2352 x 1568 pixels · color fundus photograph:
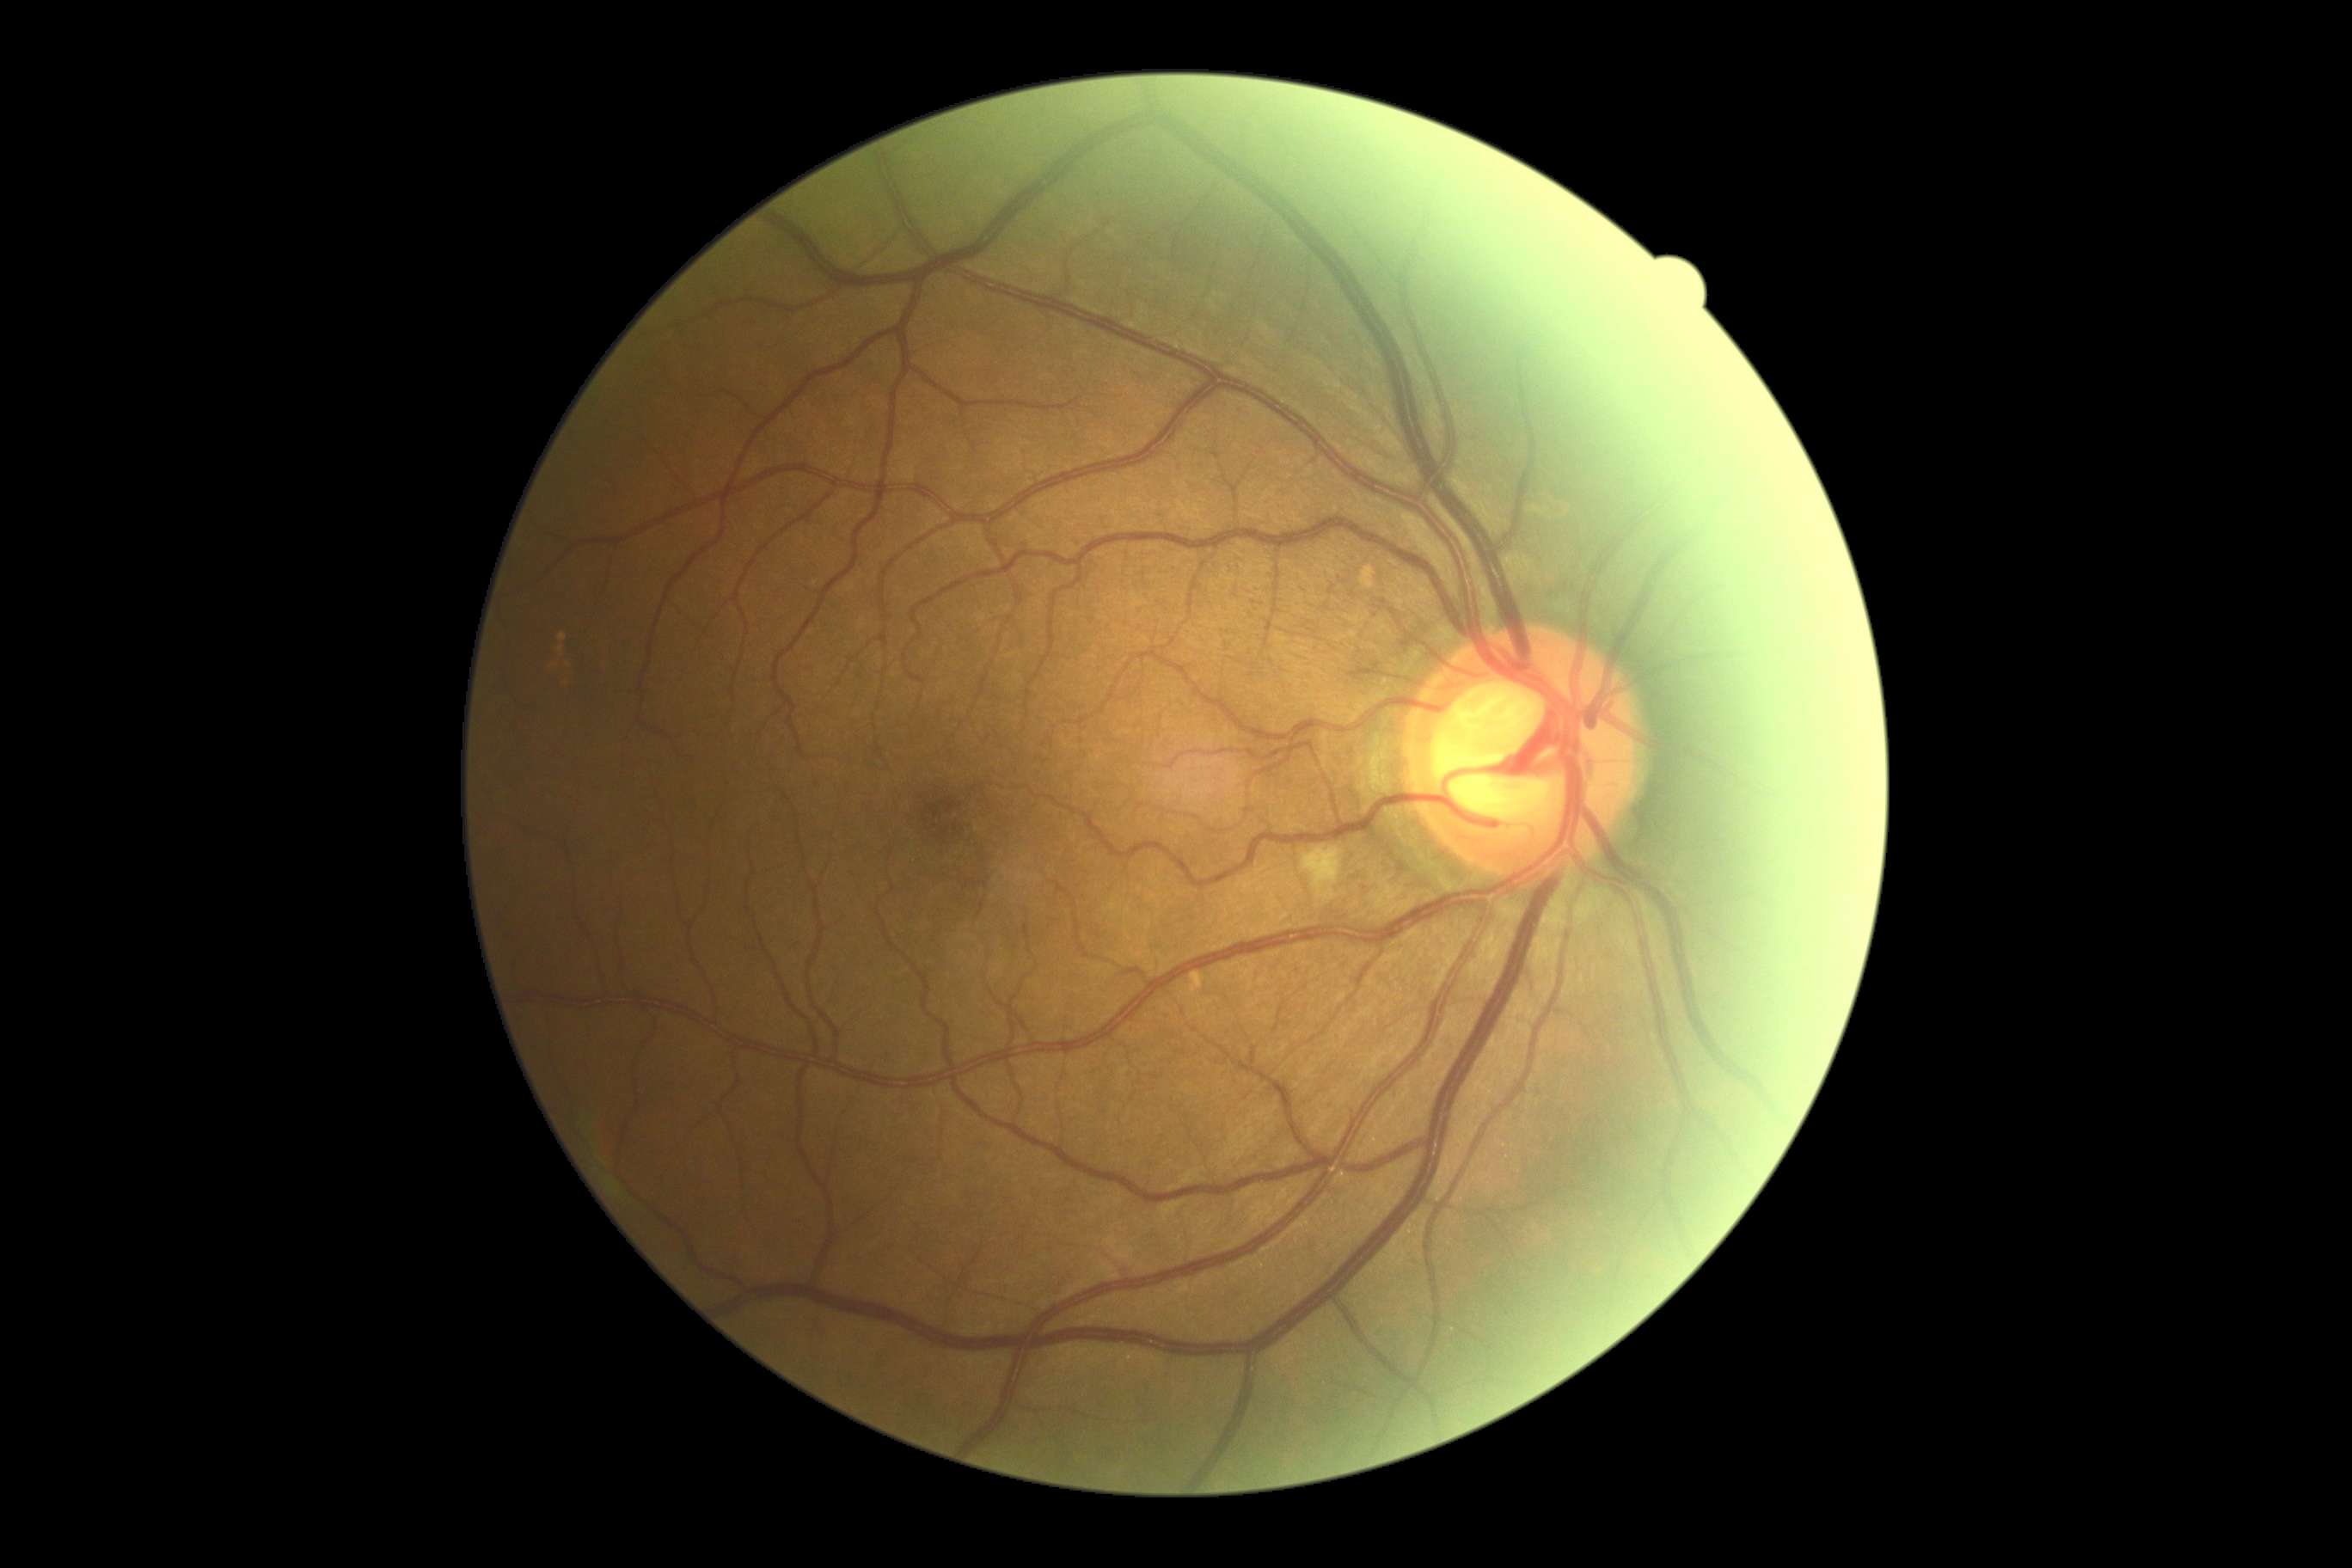 Retinopathy grade: 2/4 — more than just microaneurysms but less than severe NPDR.